2089 x 1764 pixels.
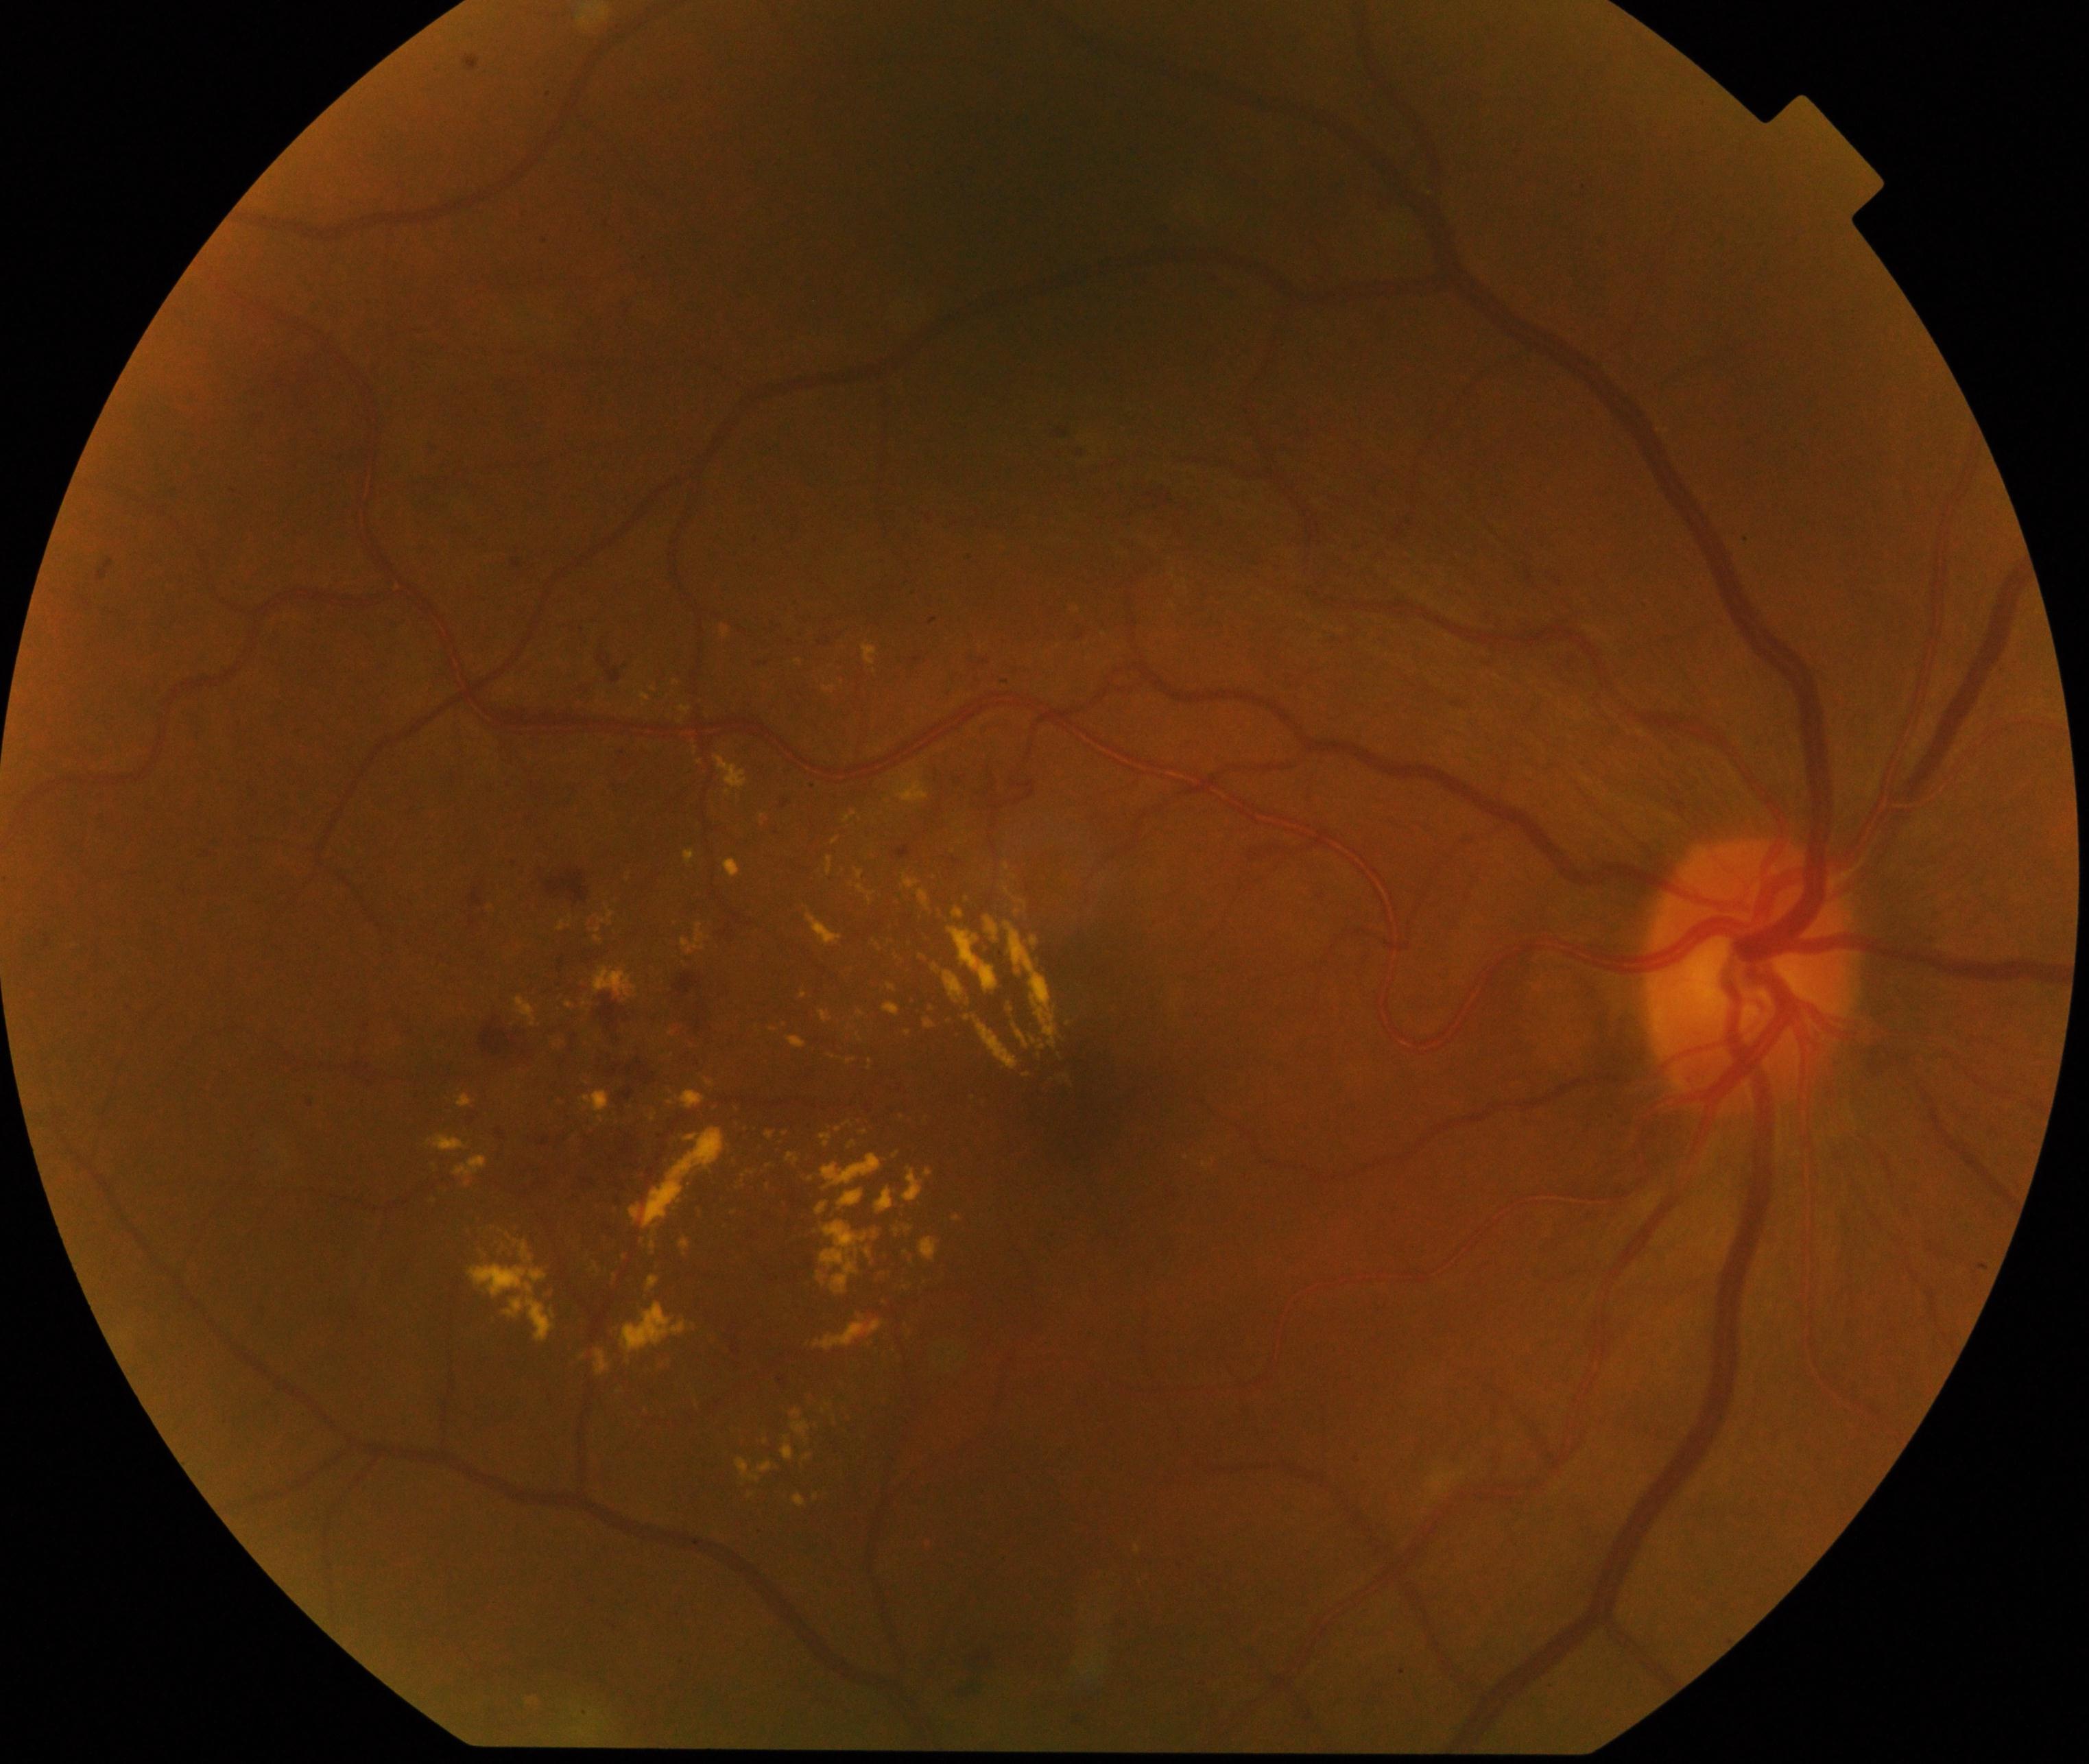
Findings: moderate non-proliferative diabetic retinopathy.